Phoenix ICON, 100° FOV; Phoenix ICON wide-field infant fundus image: 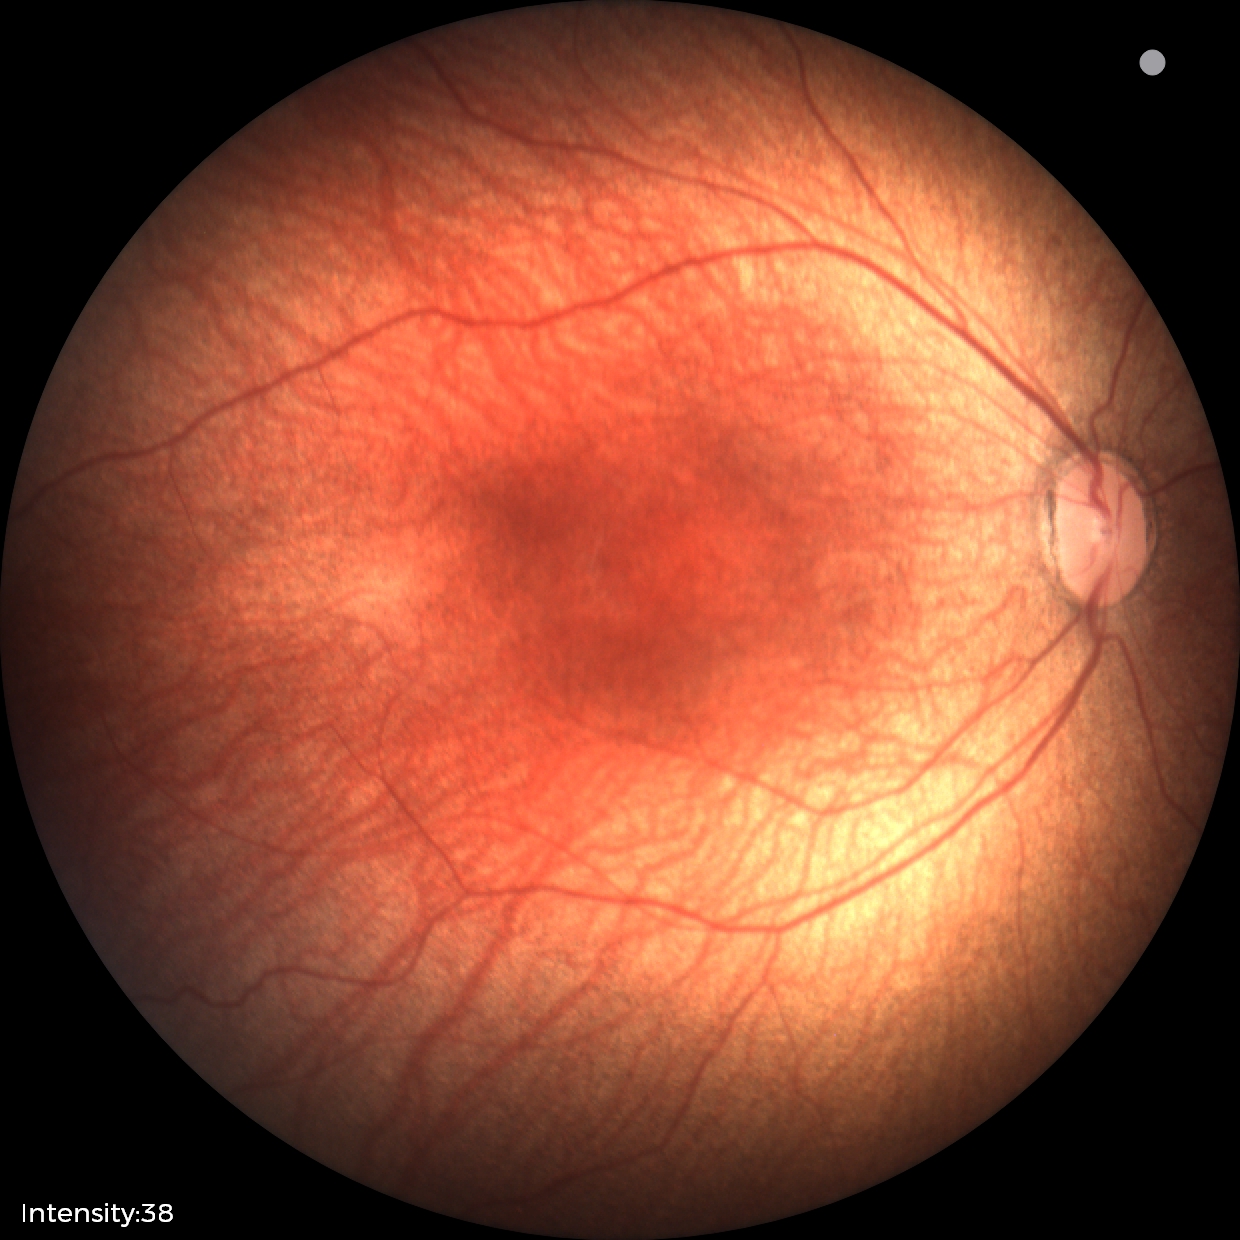

Screening series with status post ROP.